45-degree field of view, Davis DR grading — 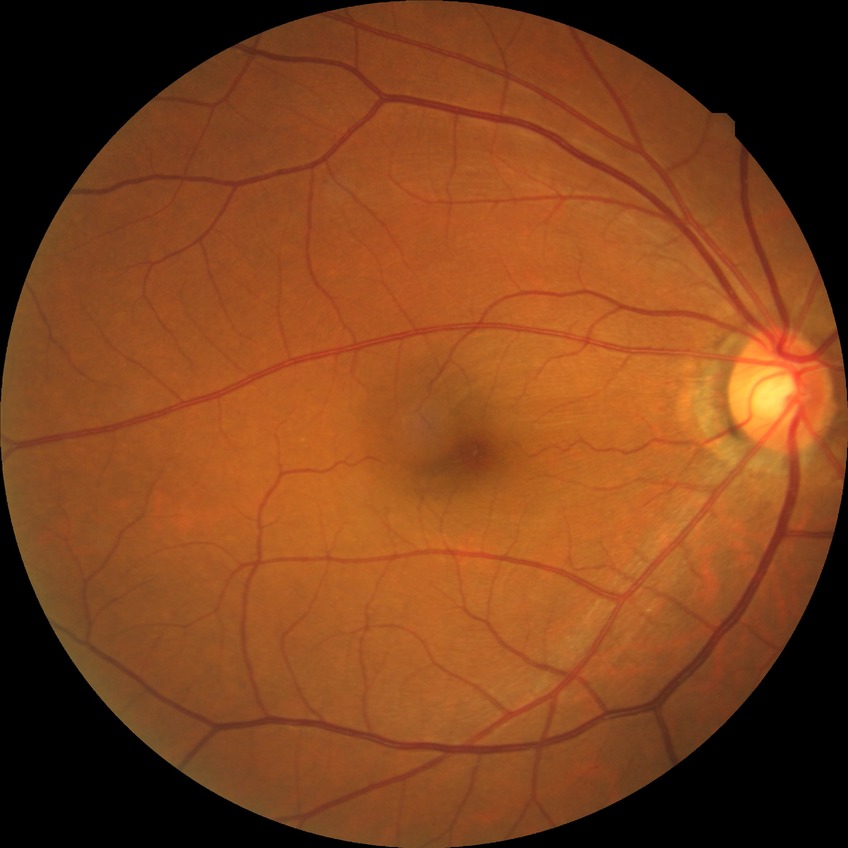
Diabetic retinopathy (DR): NDR (no diabetic retinopathy).